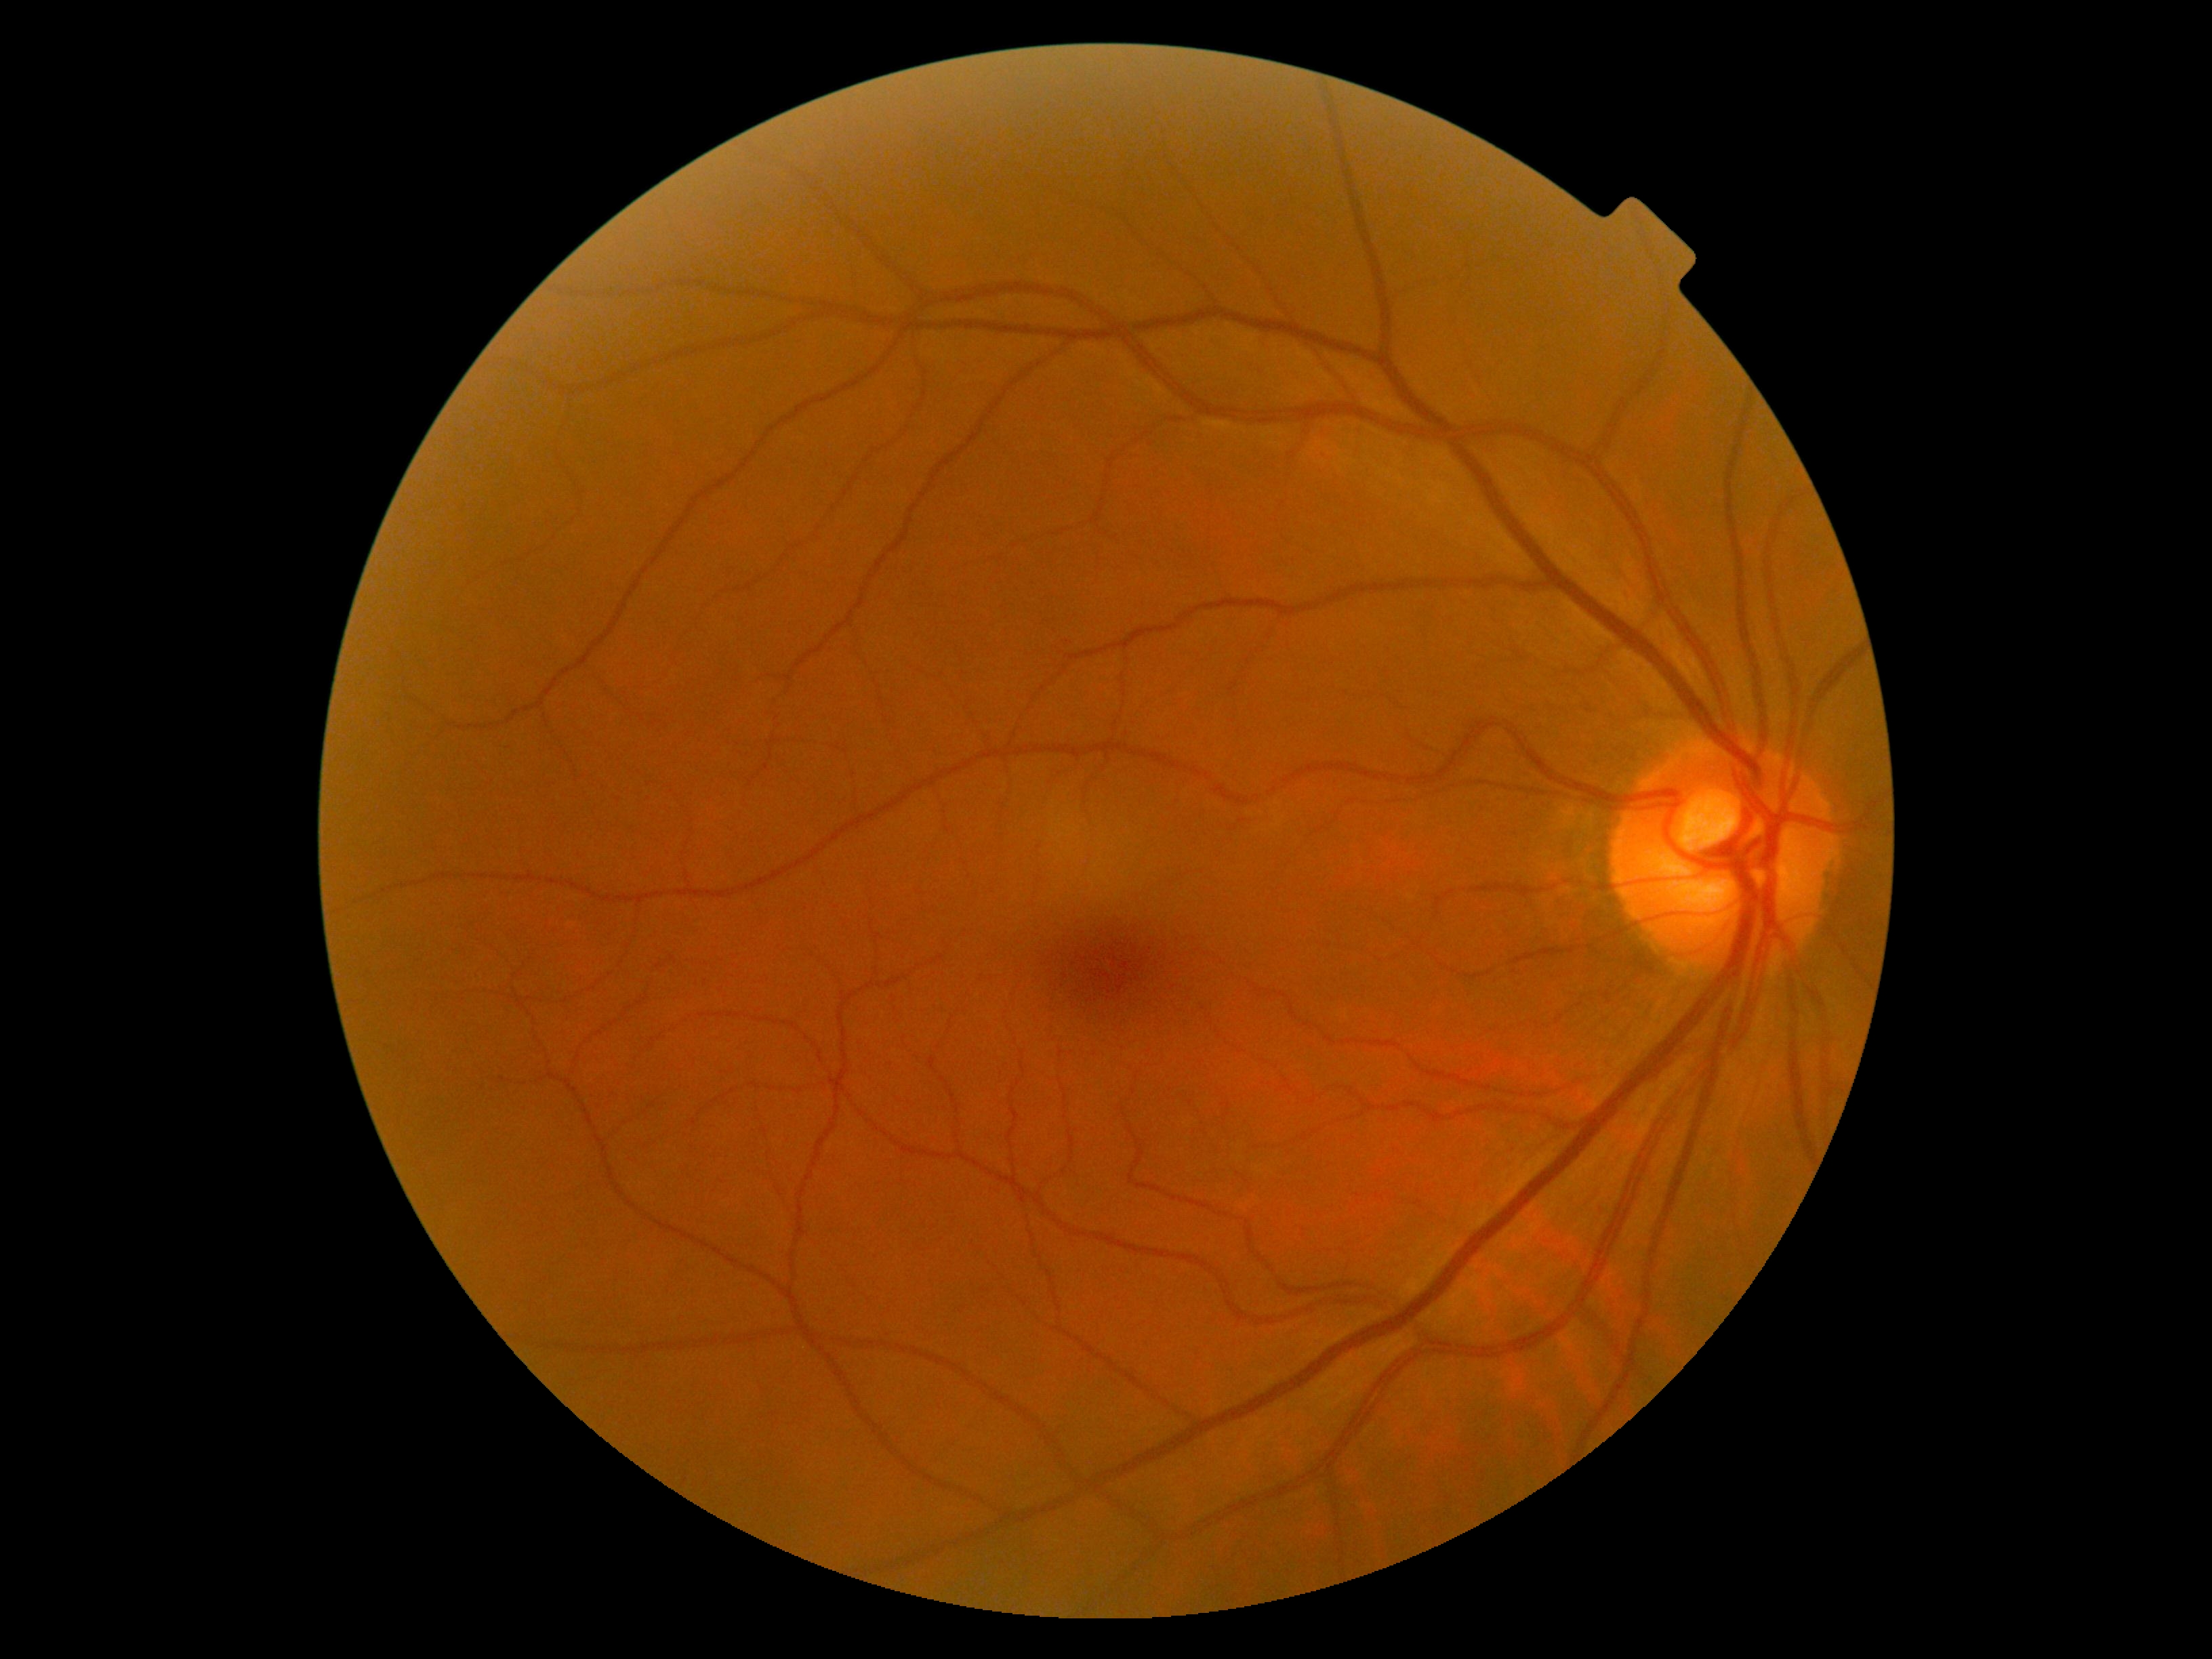

{
  "dr_impression": "negative for DR",
  "dr_grade": "no apparent retinopathy (0)"
}